Phoenix ICON wide-field infant fundus image · 1240x1240px — 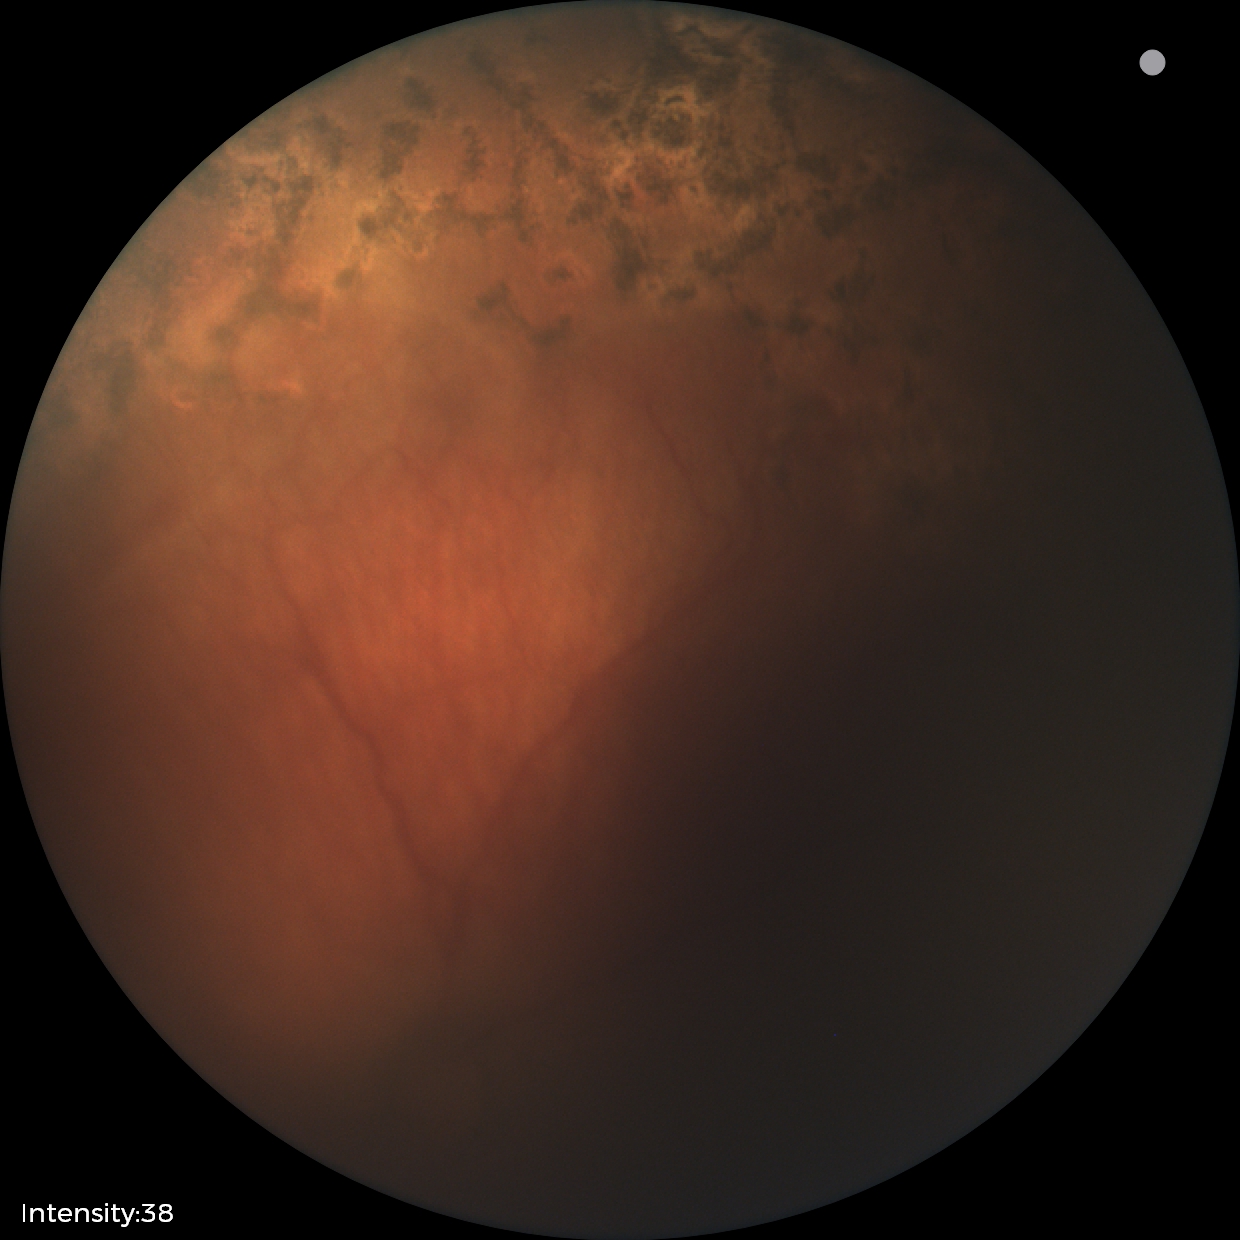

Assessment: status post ROP.